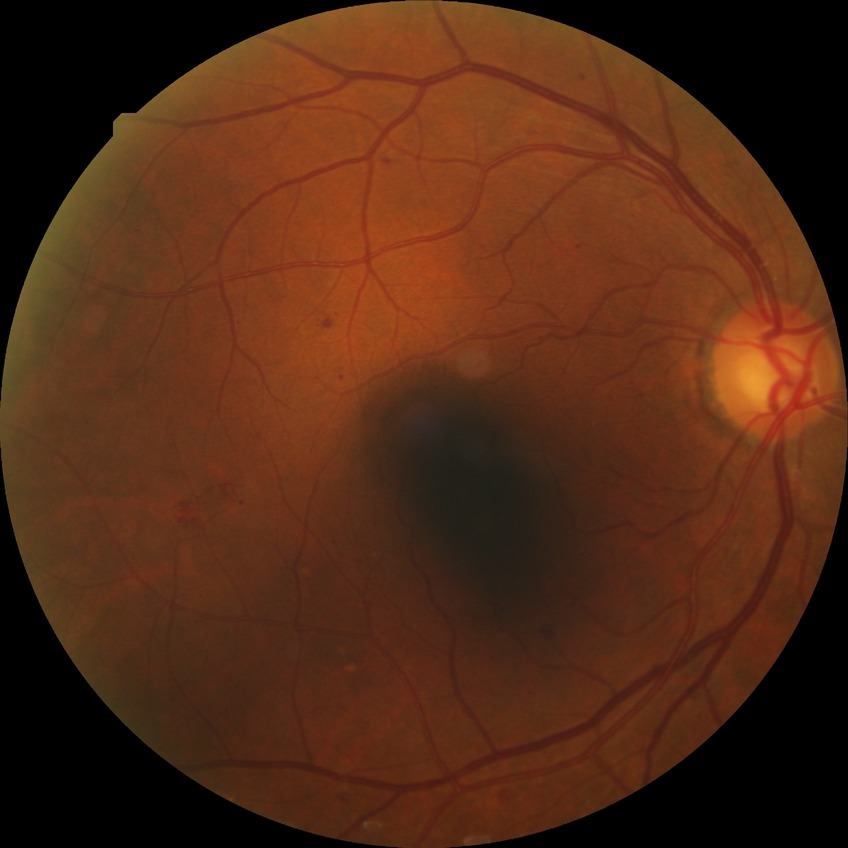

Retinopathy stage: simple diabetic retinopathy.